45° FOV · fundus photo · 1932x1916.
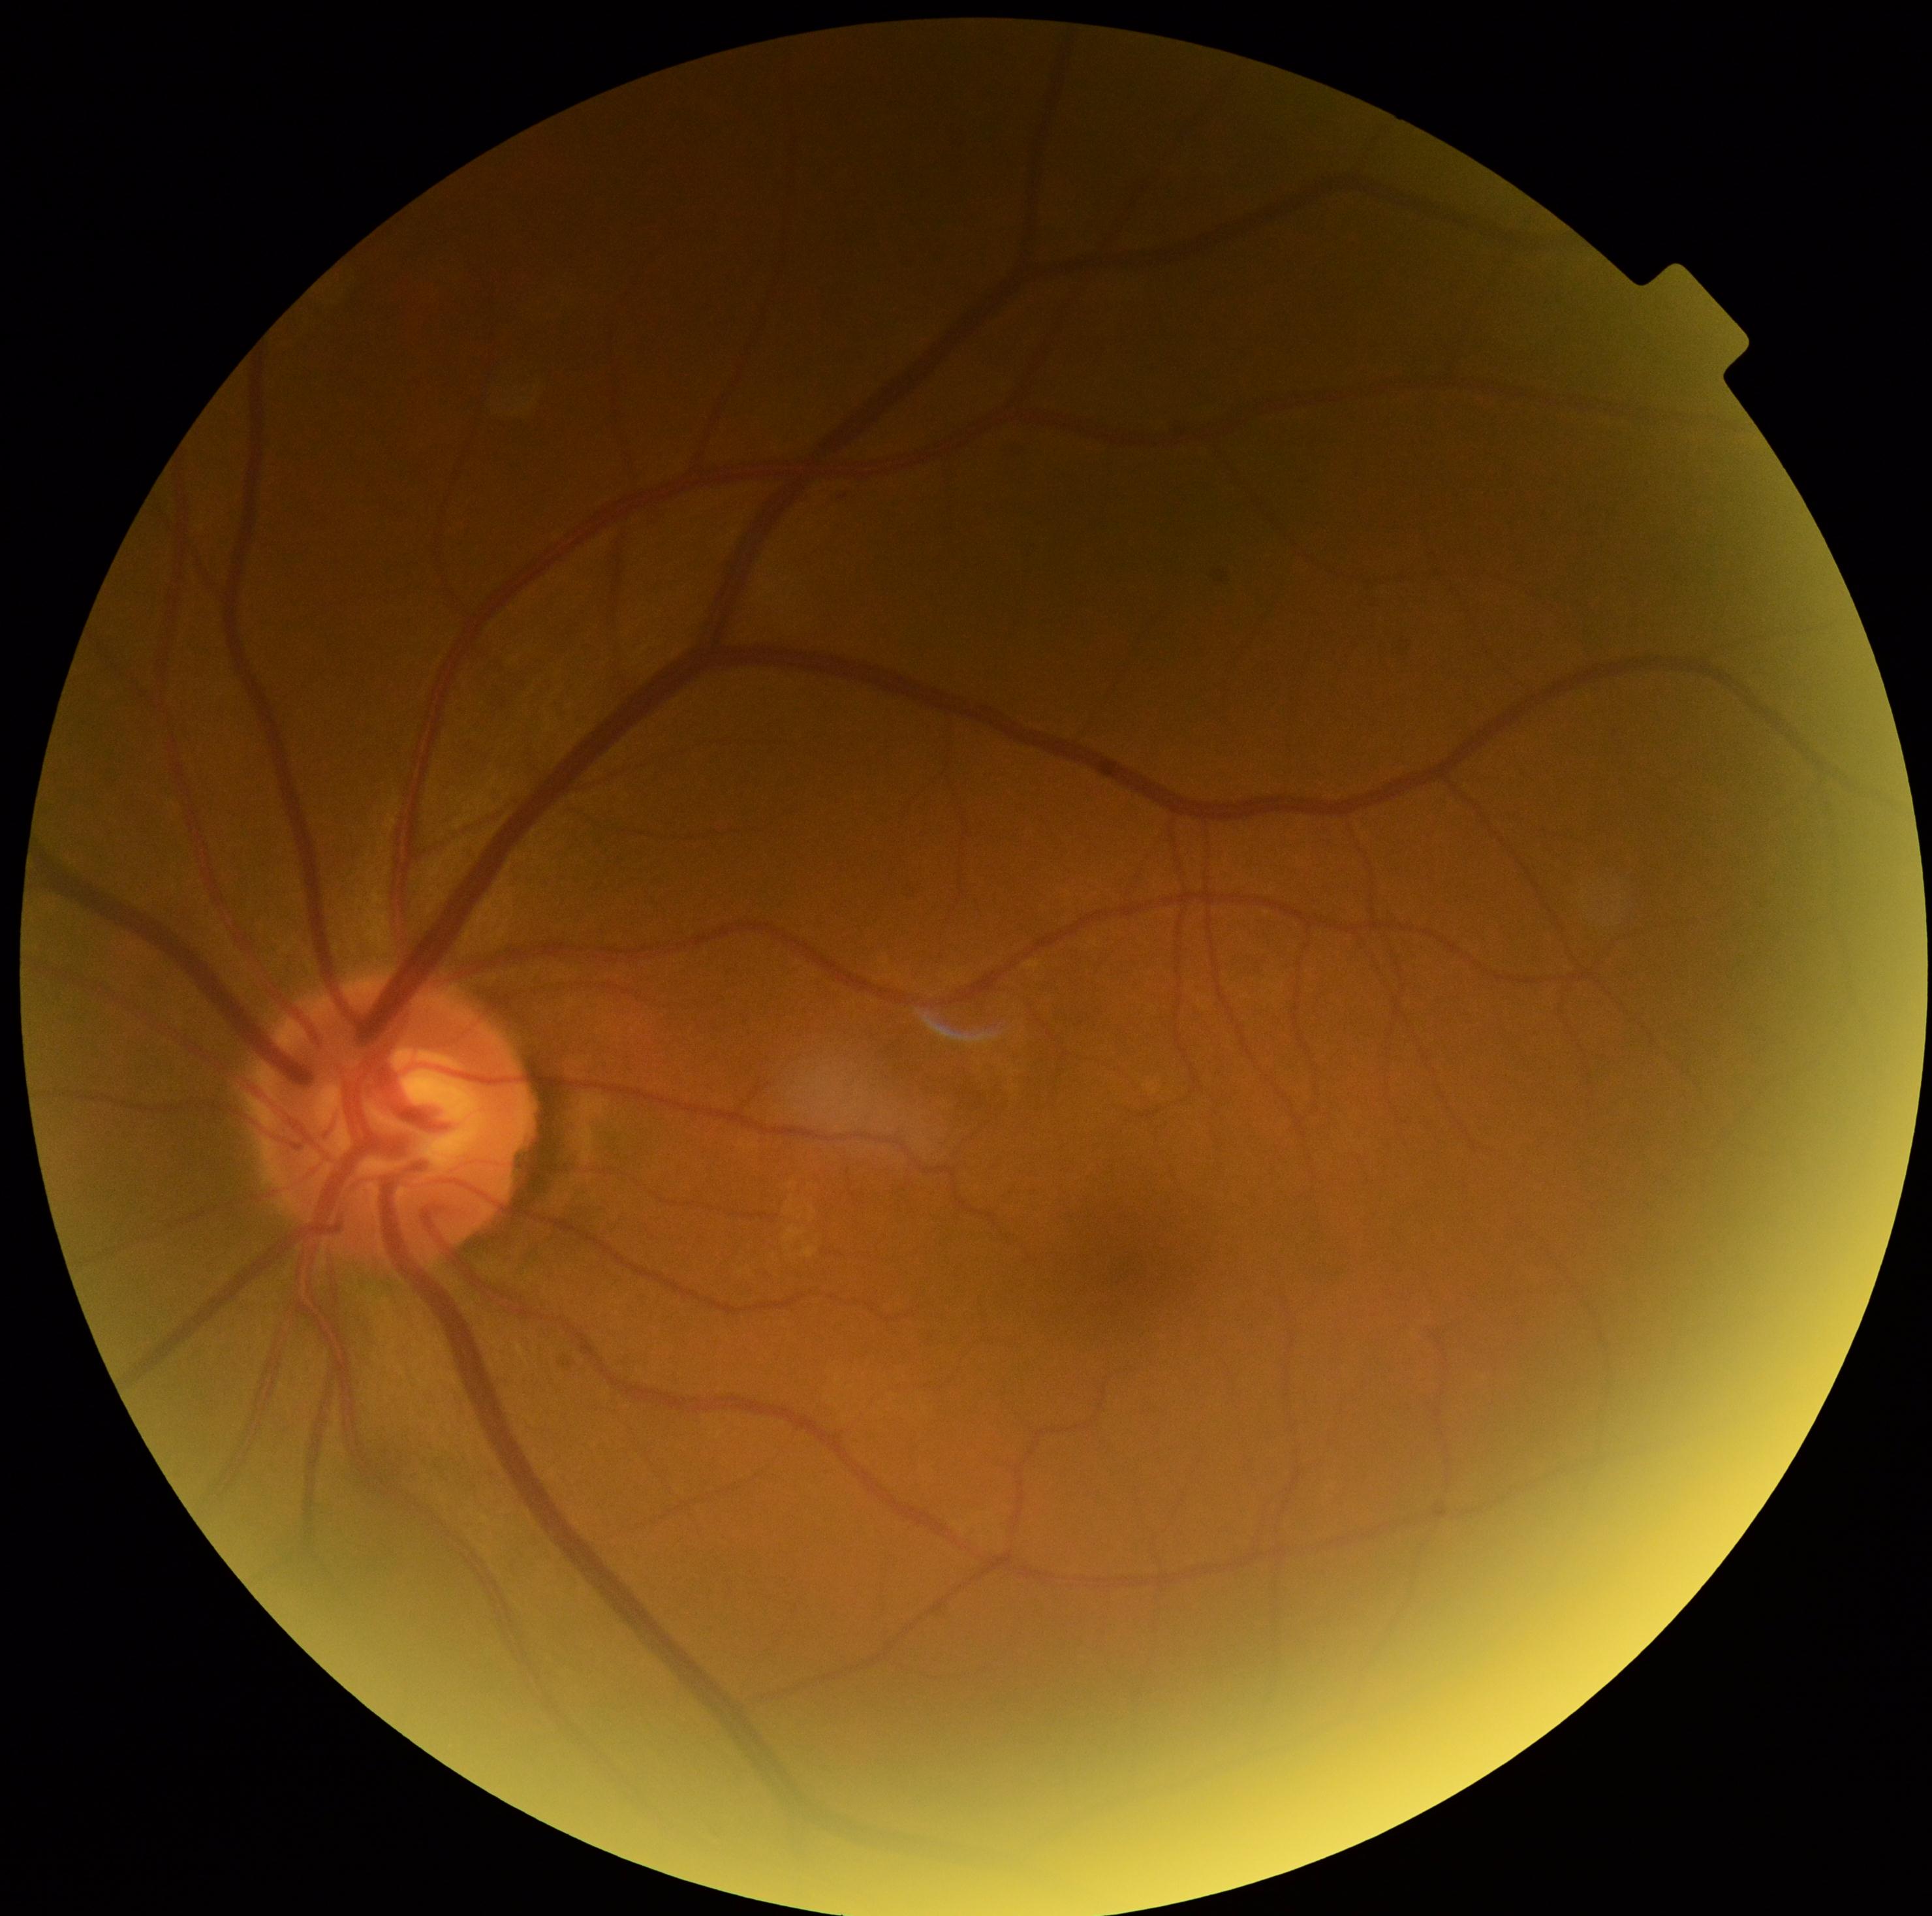

Findings:
– retinopathy grade: 0 — no visible signs of diabetic retinopathy